1659 x 2212 pixels, acquired with a Remidio Fundus on Phone: 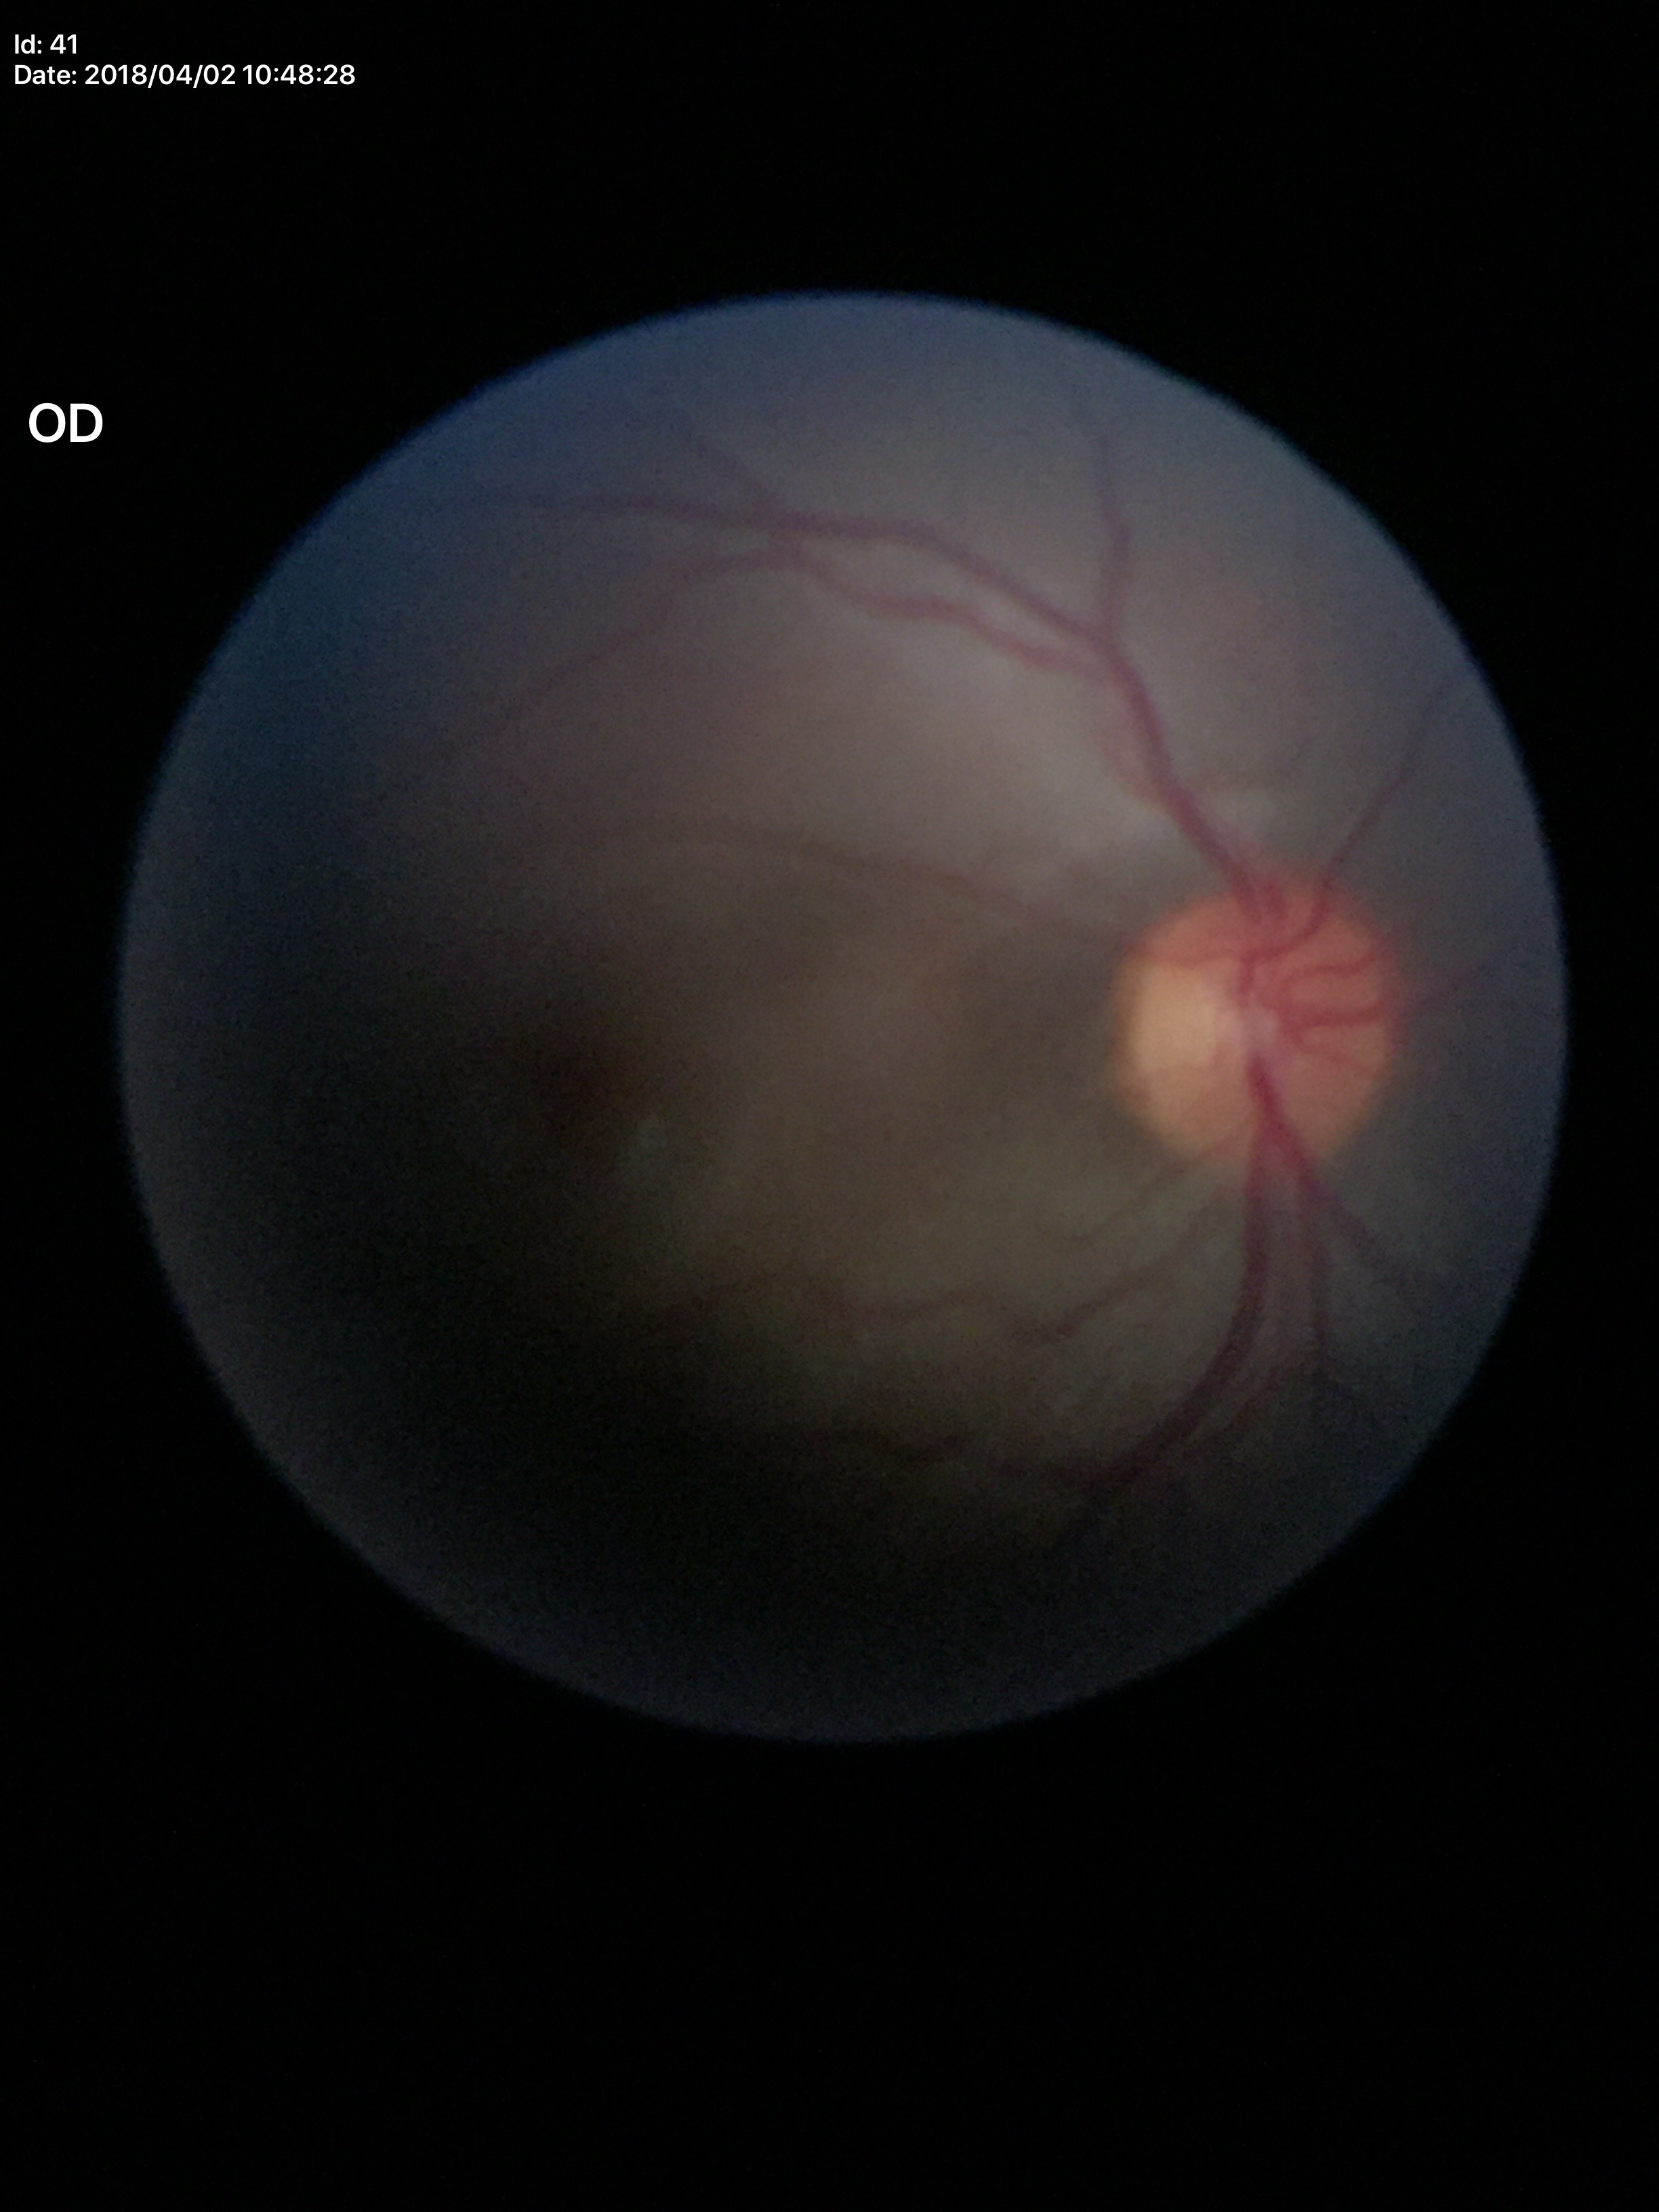
Optic disc analysis:
- vertical CDR: 0.43
- Glaucoma screening impression: not suspect
- horizontal cup-disc ratio: 0.42